2048x1536:
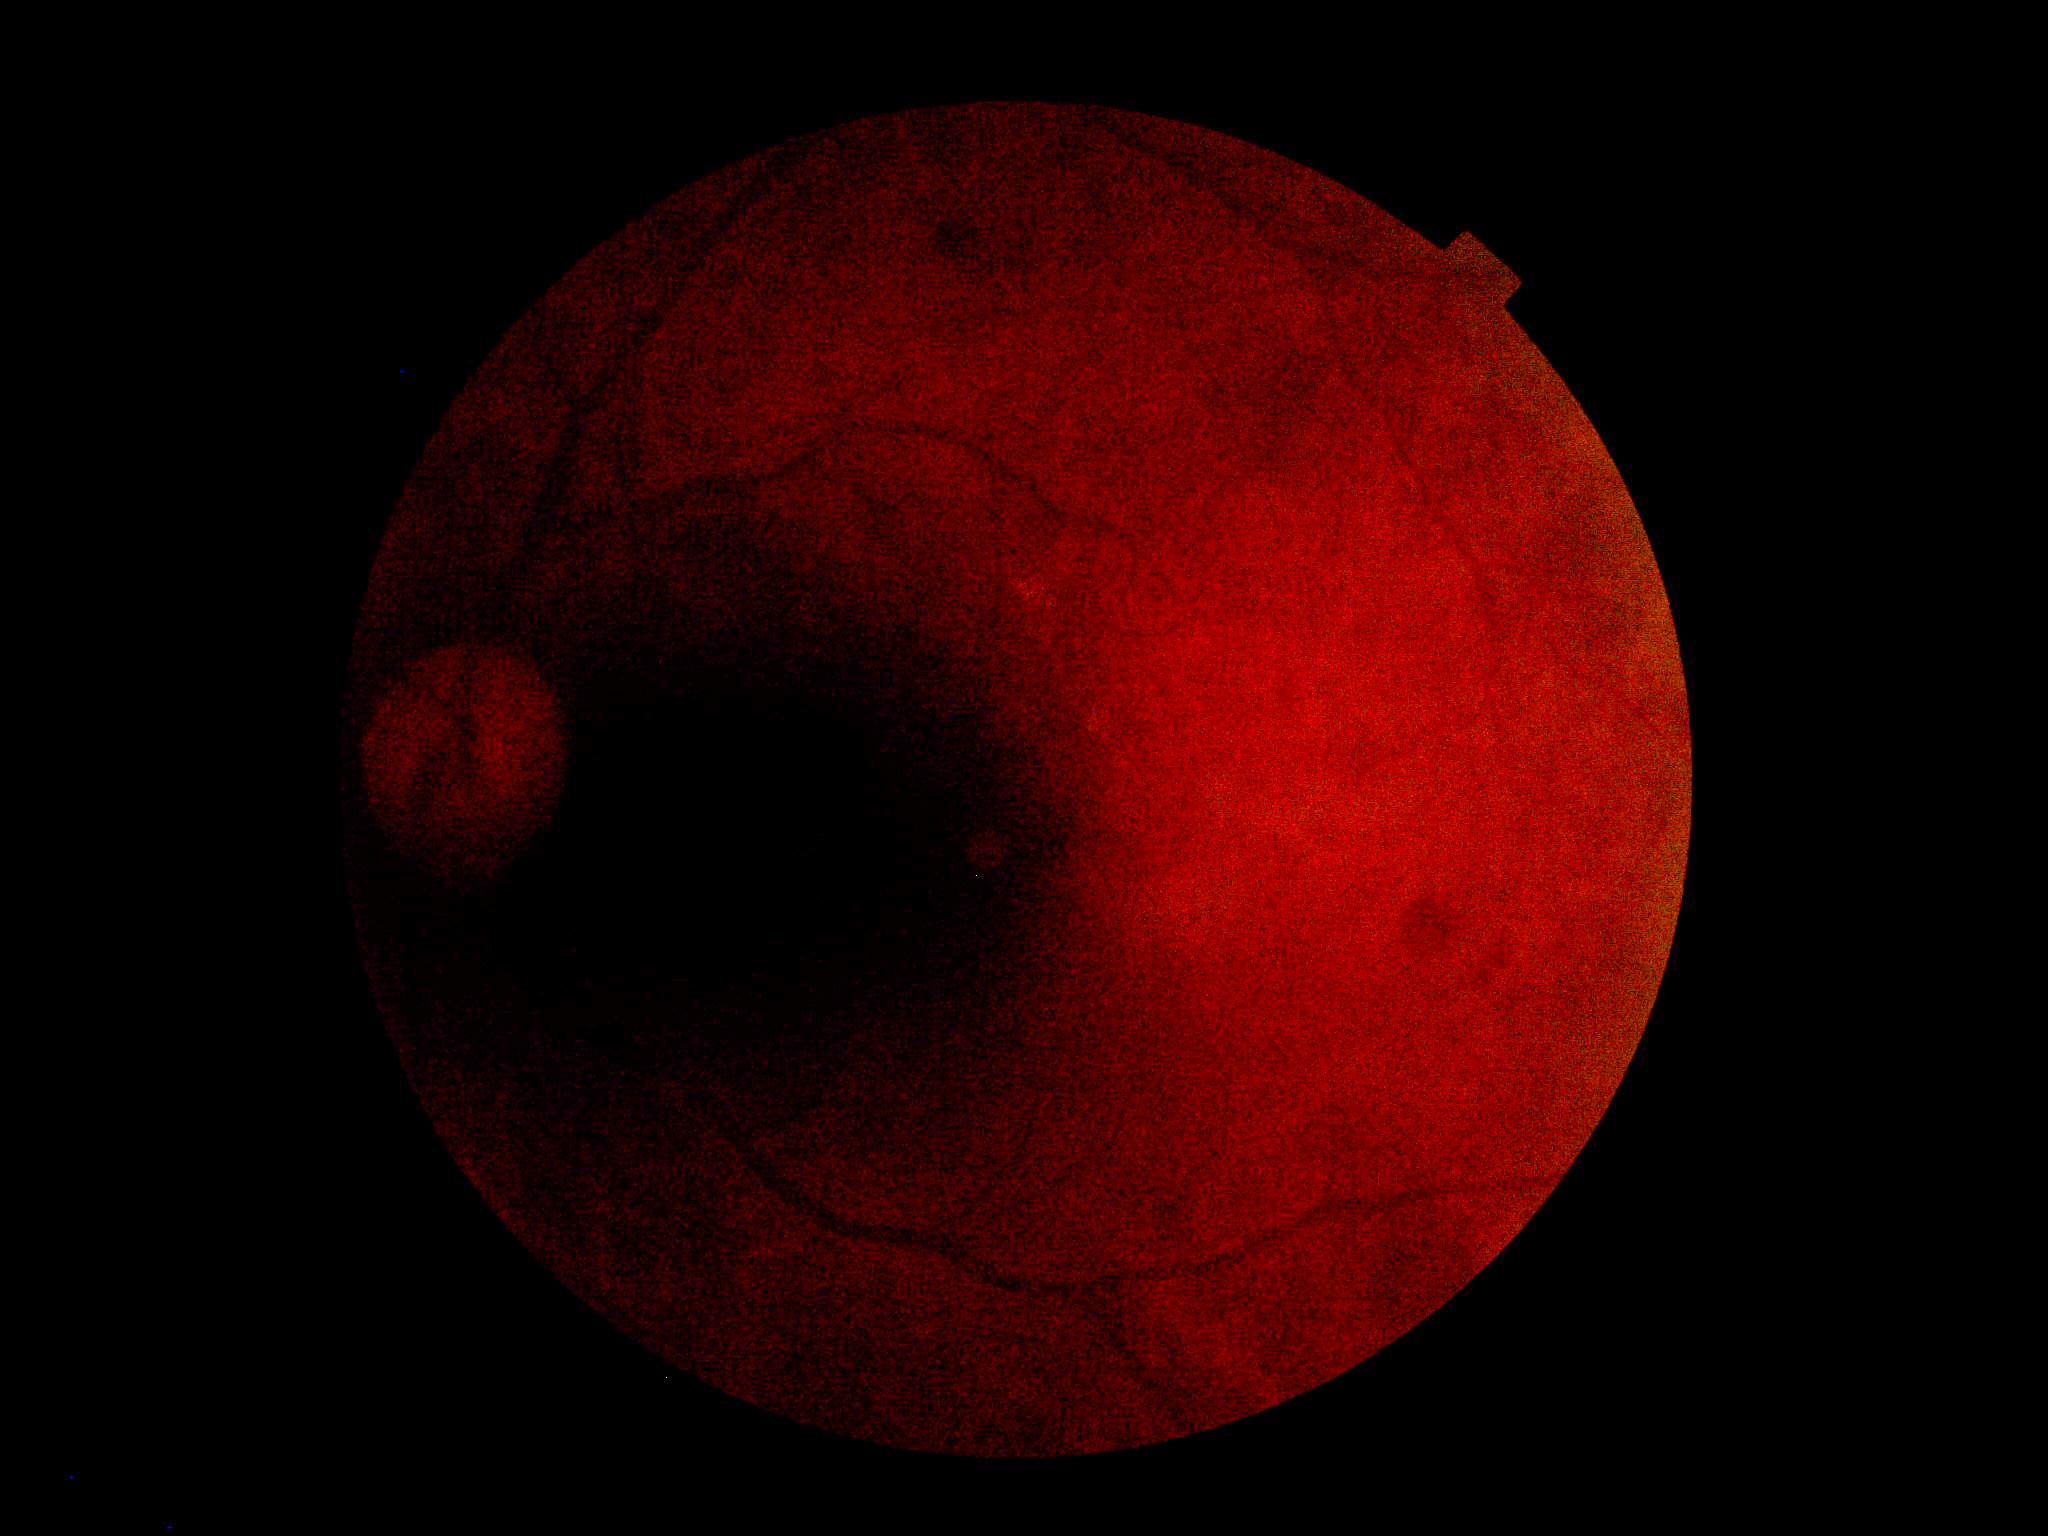

Quality too poor to assess for DR.
Retinopathy is ungradable due to poor image quality.